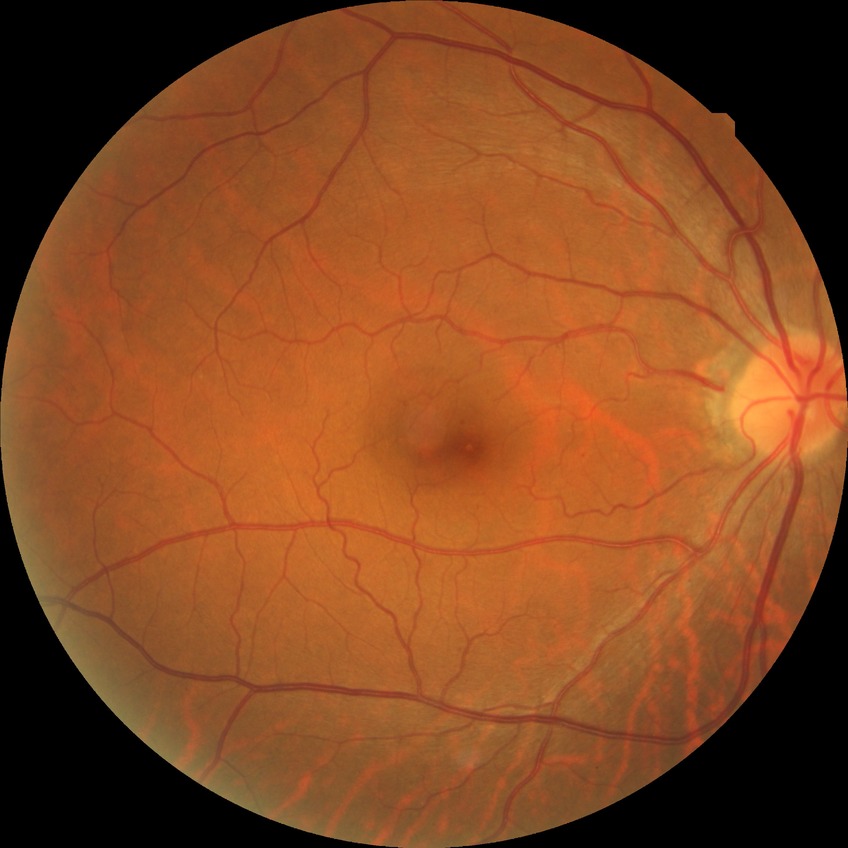
Diabetic retinopathy (DR): NDR (no diabetic retinopathy).